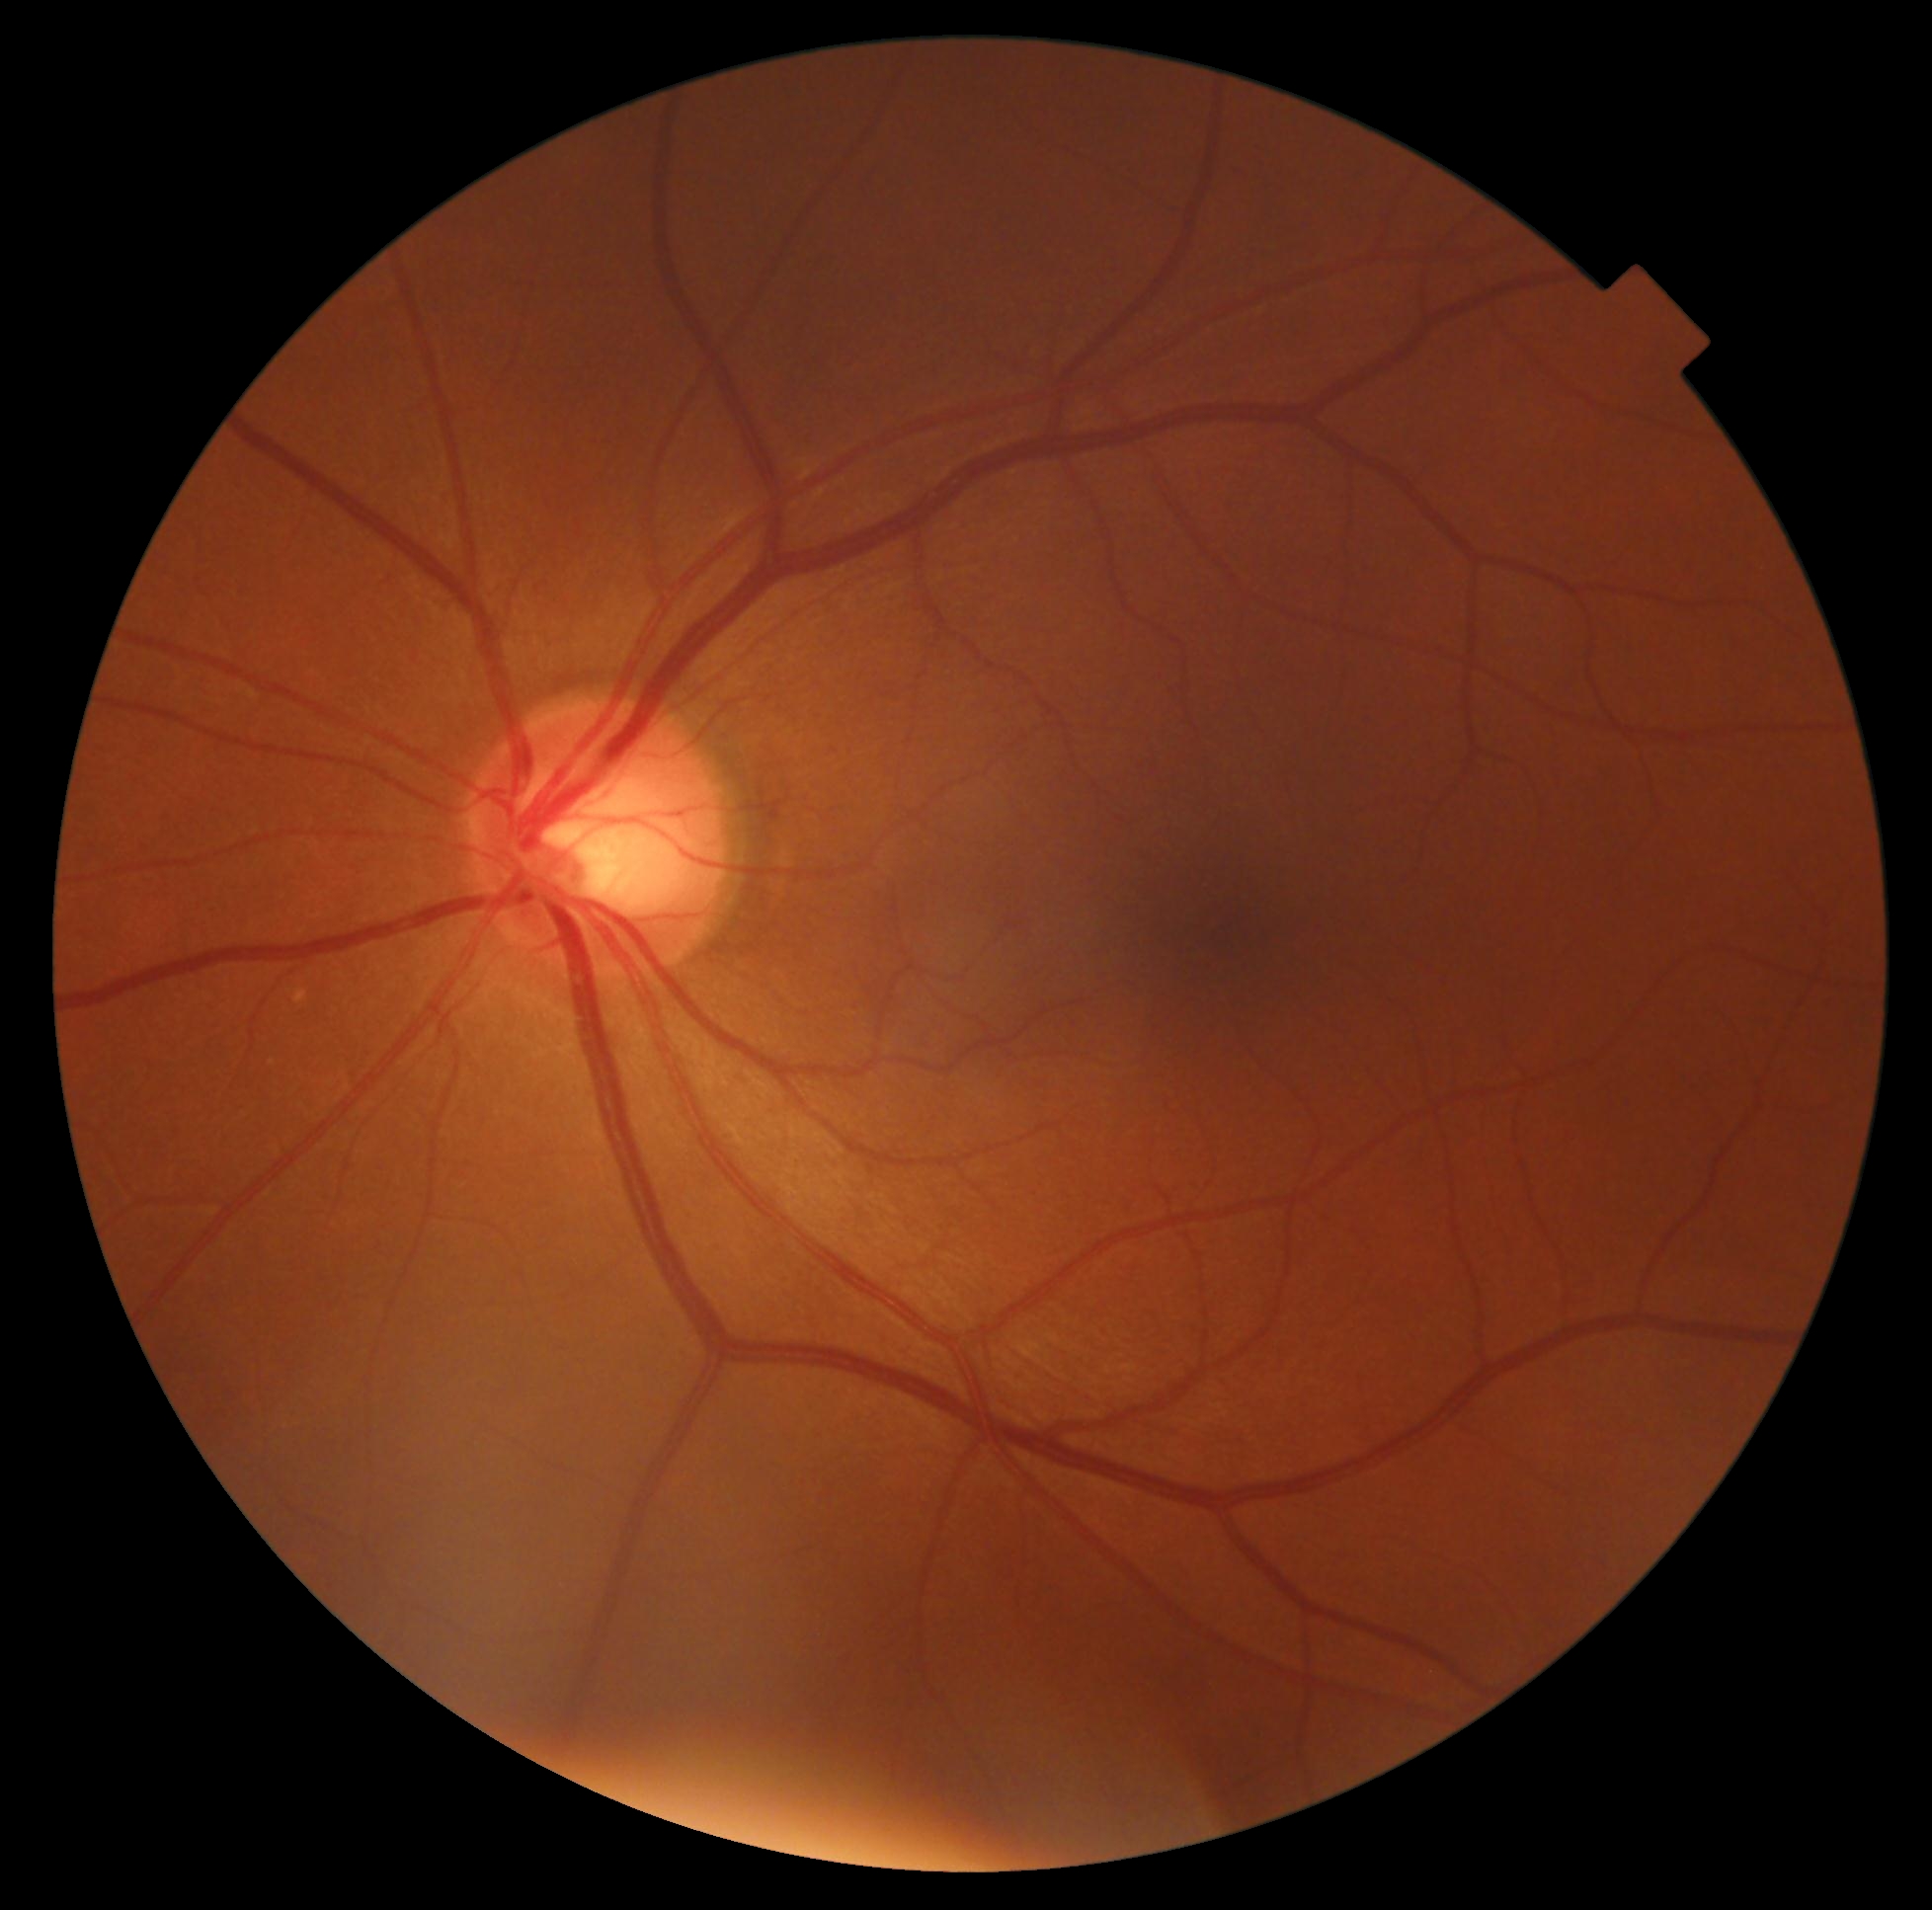

DR grade: 0/4.
No DR findings.